2352x1568 — 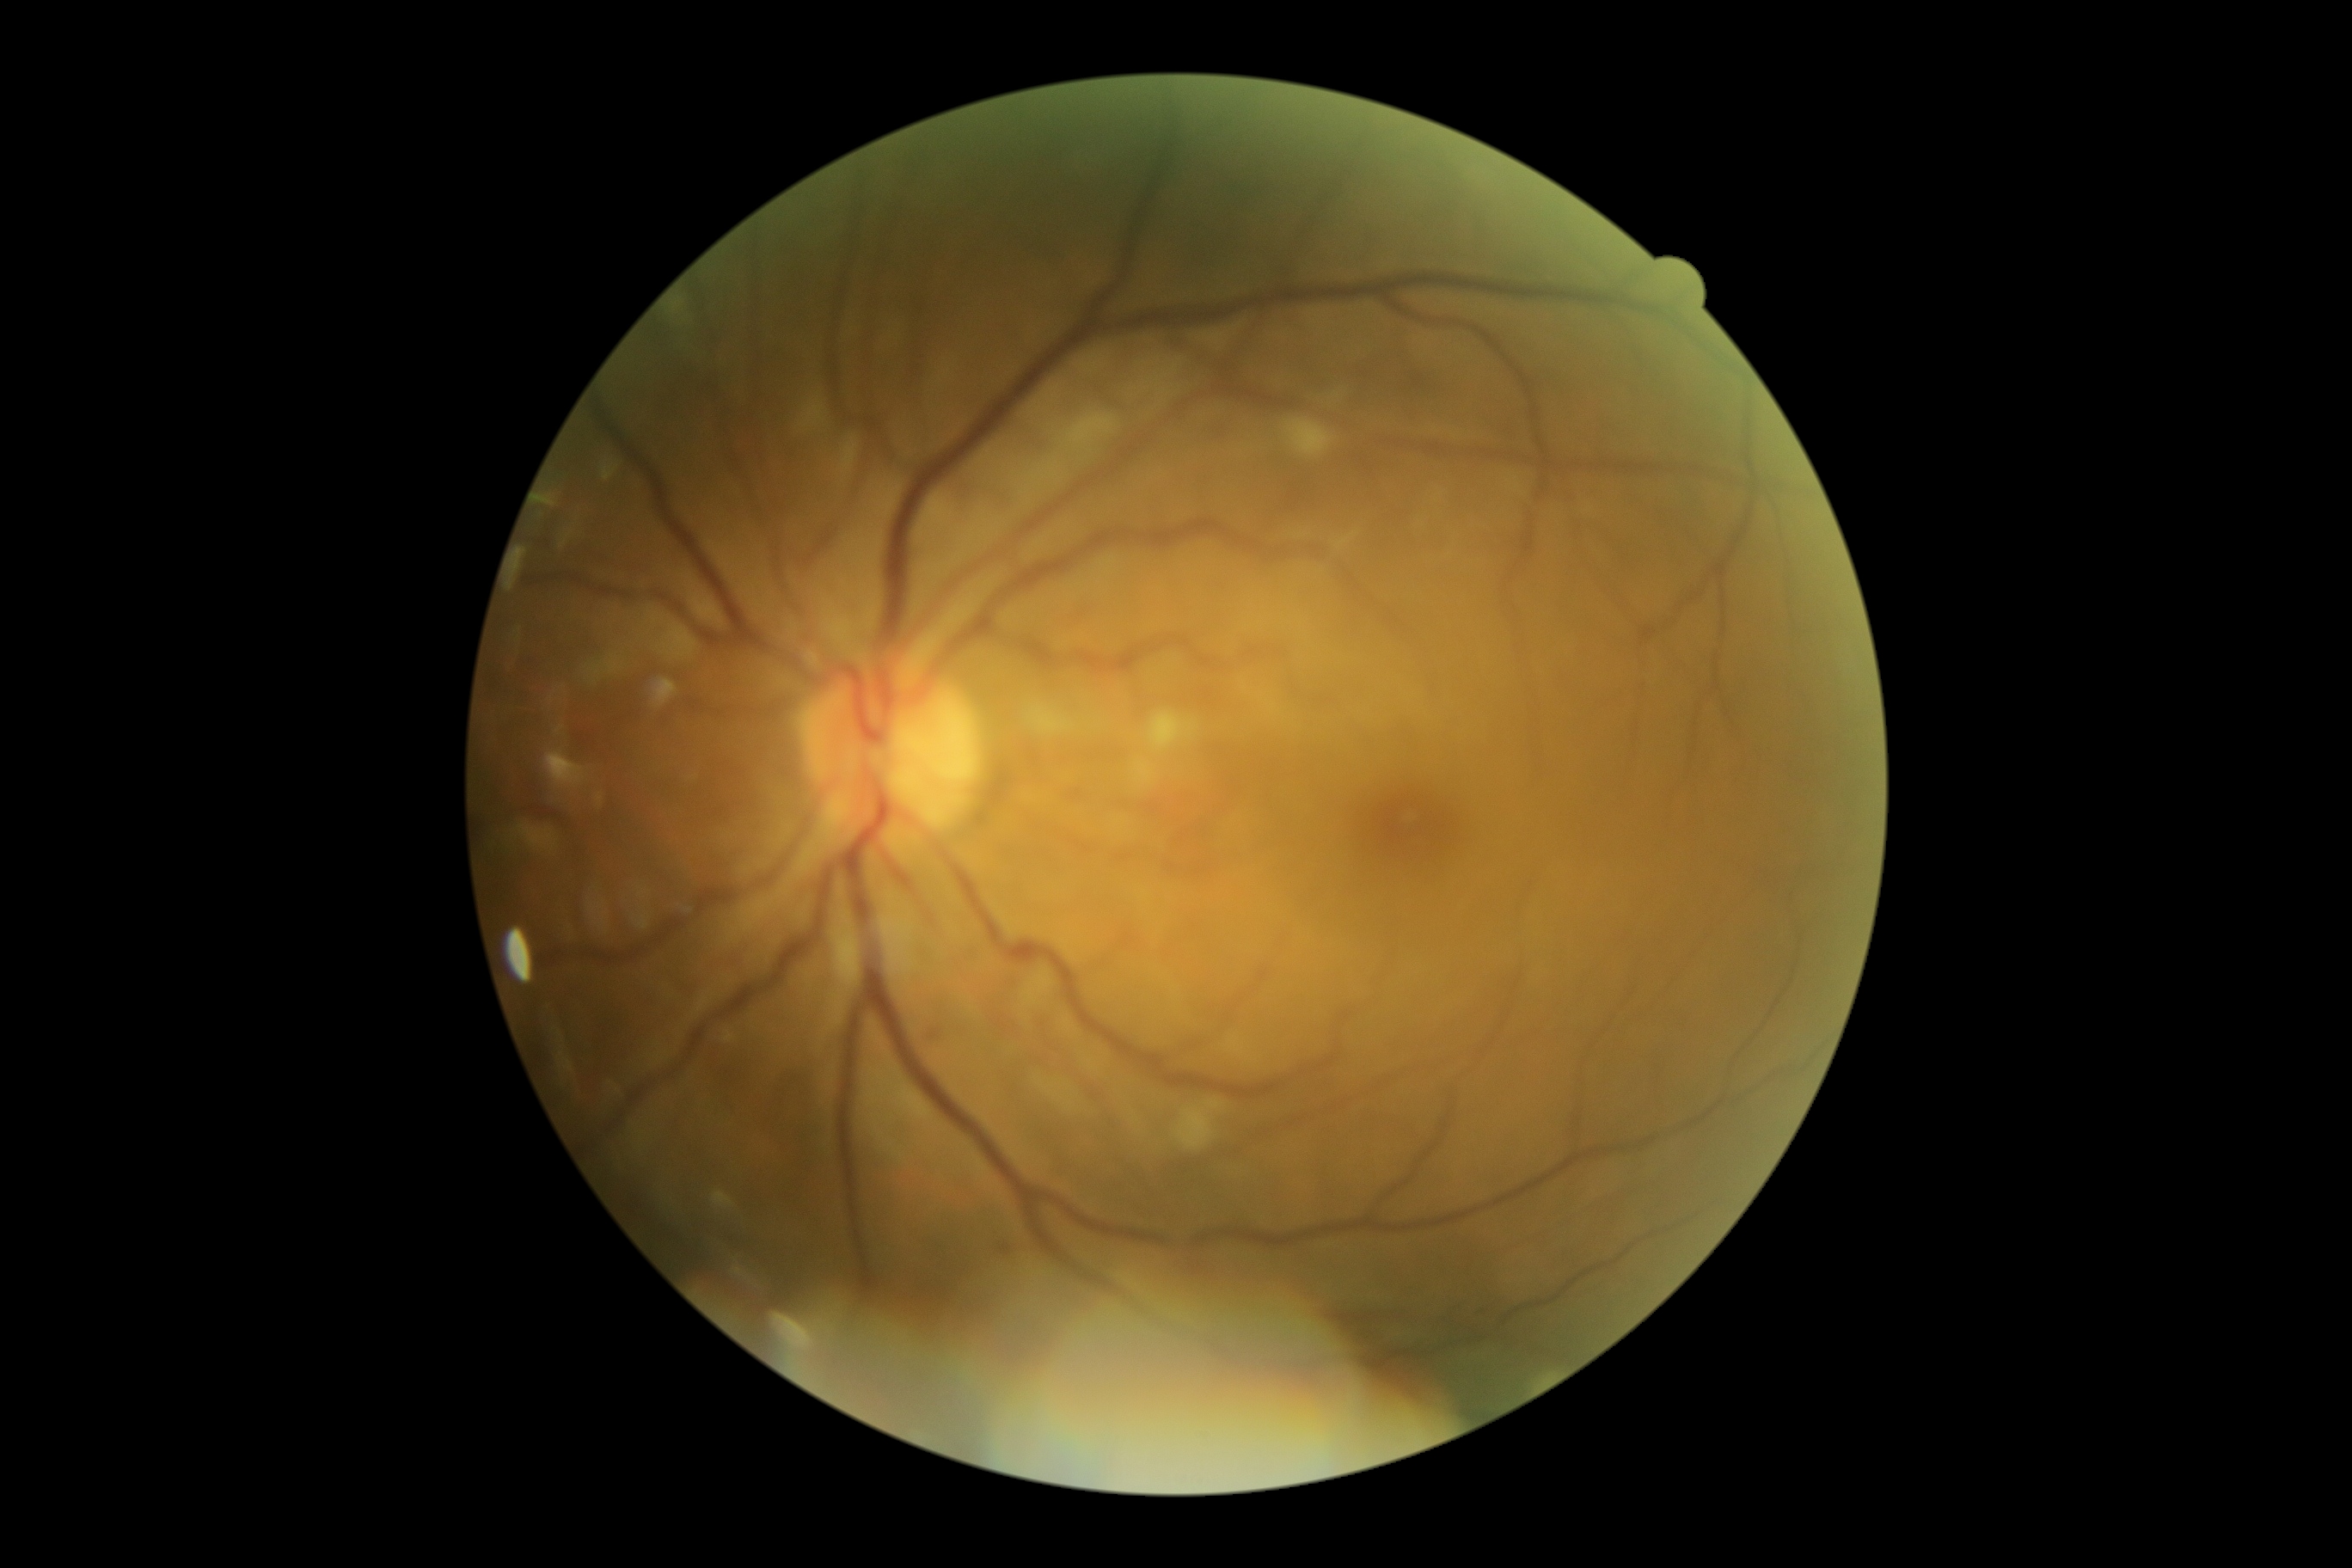 DR stage: moderate NPDR (grade 2).
DR class: non-proliferative diabetic retinopathy.